Diabetic retinopathy graded by the modified Davis classification · 45 degree fundus photograph · 848x848px · color fundus image:
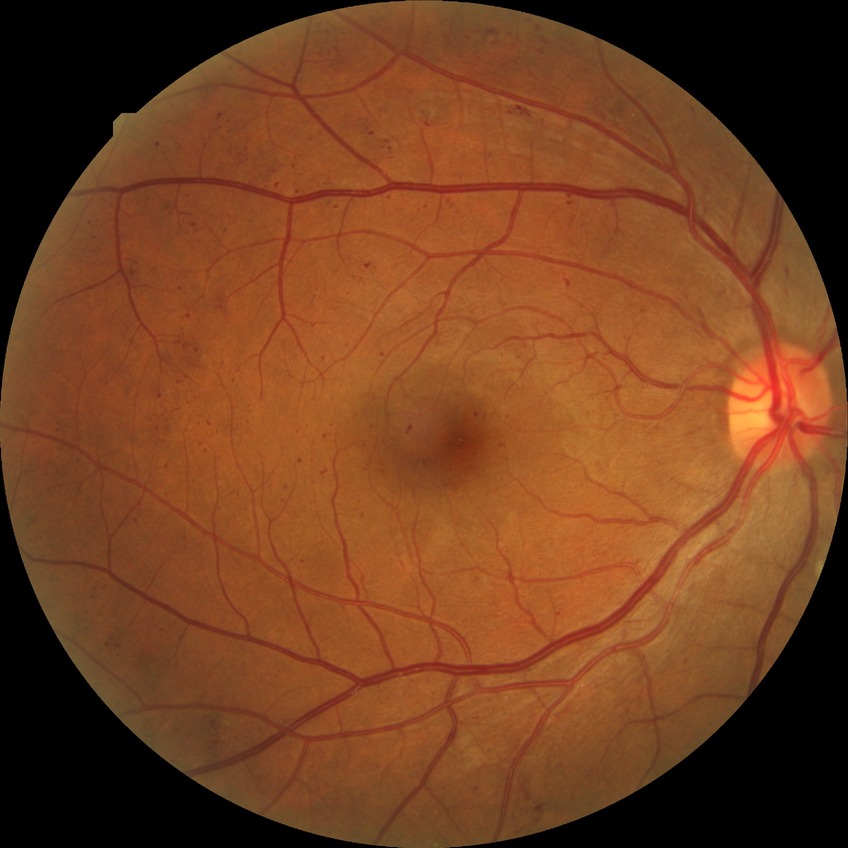

DR severity: PPDR.